FOV: 45 degrees — 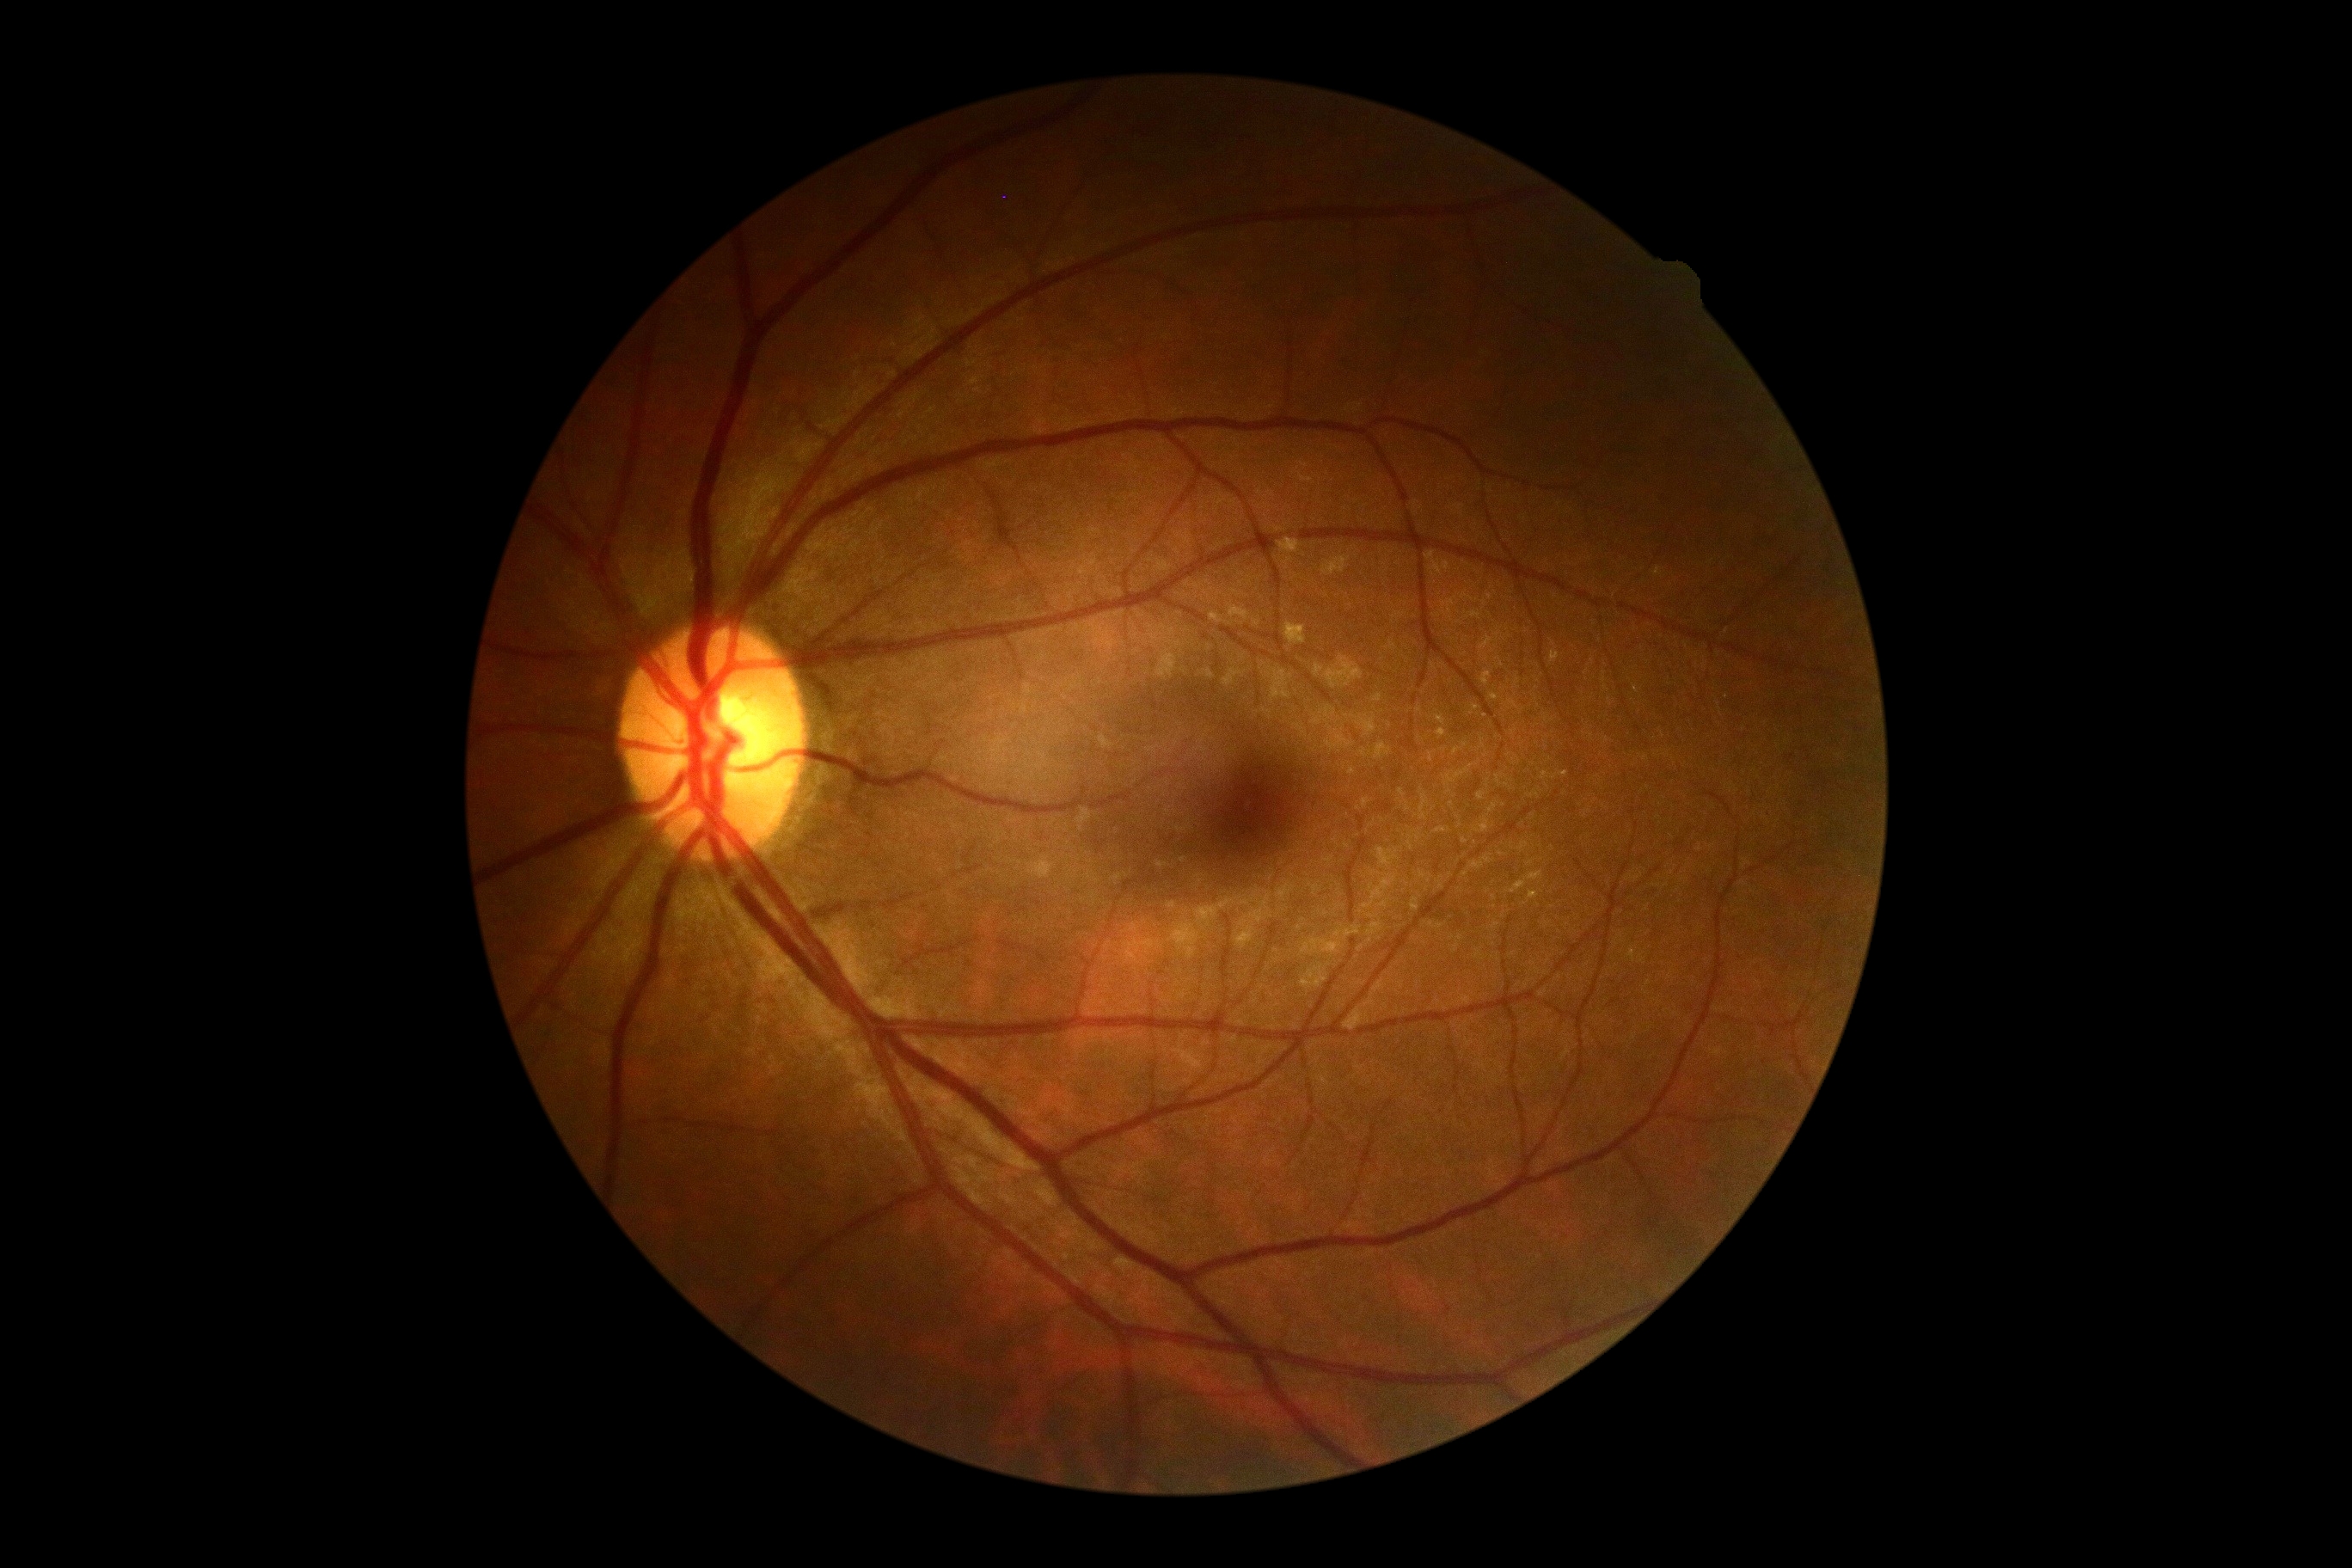 DR grade is no apparent diabetic retinopathy (0).